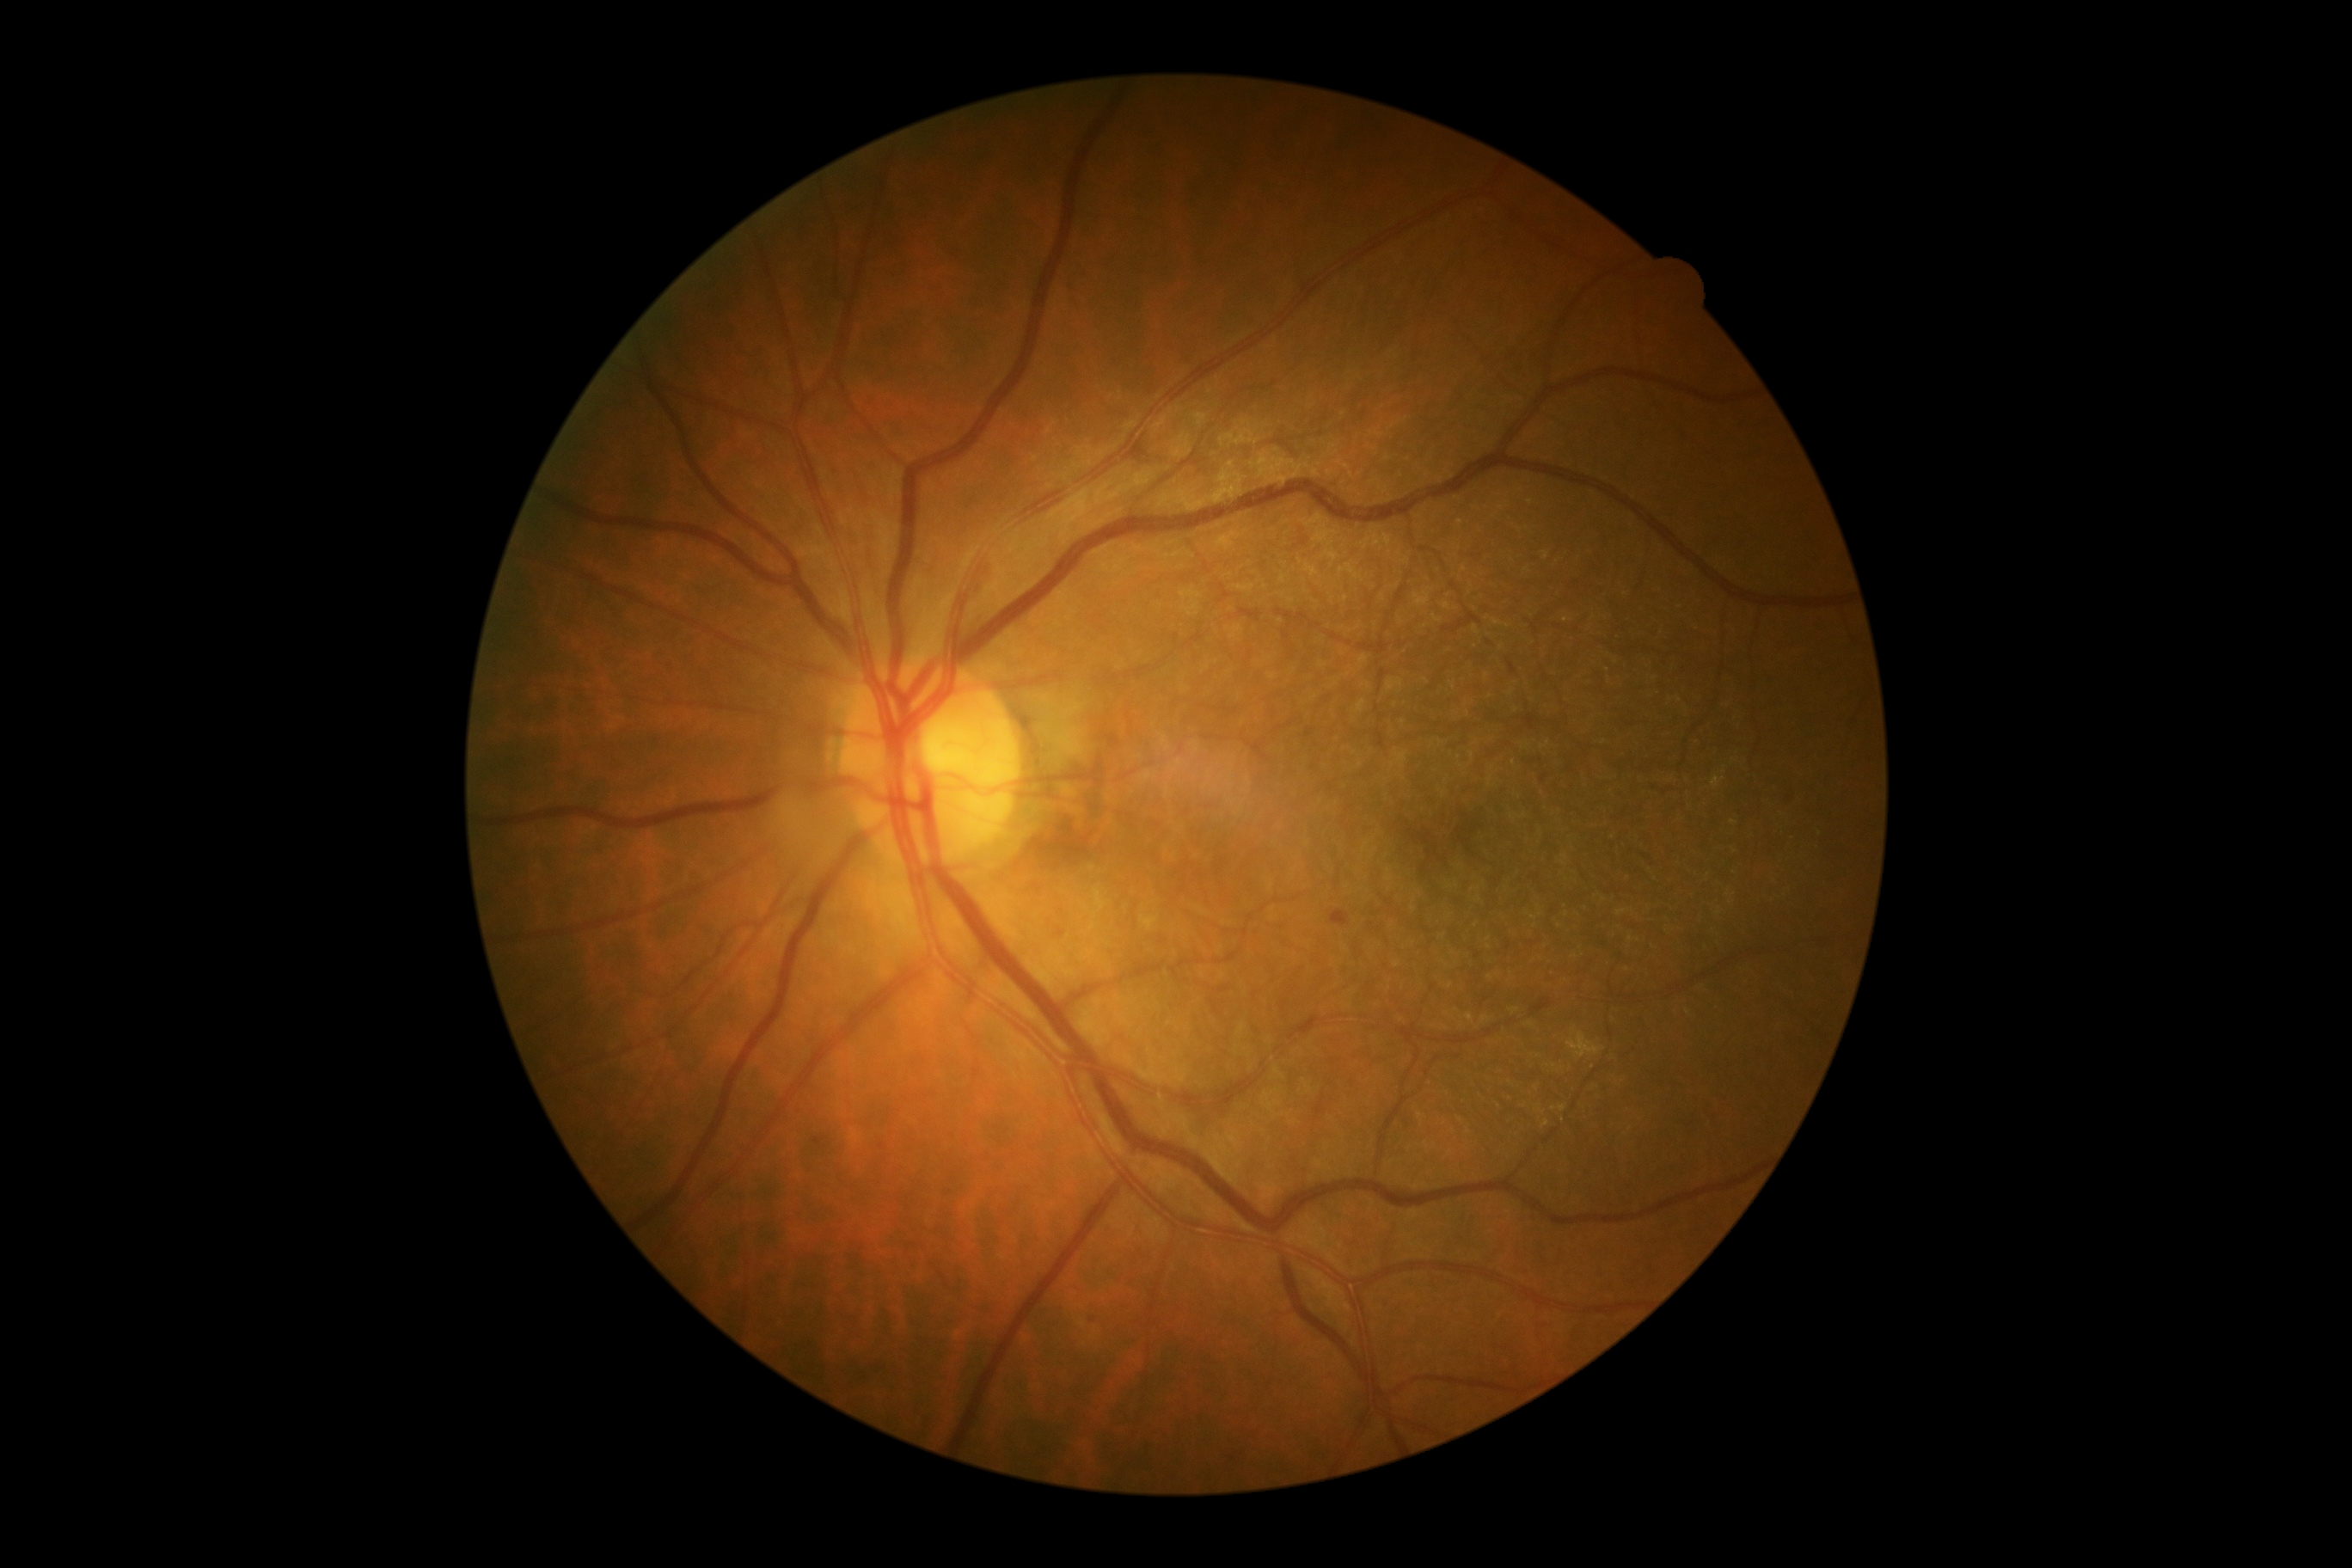
DR grade = mild NPDR (1).